Infant wide-field fundus photograph · 640 x 480 pixels:
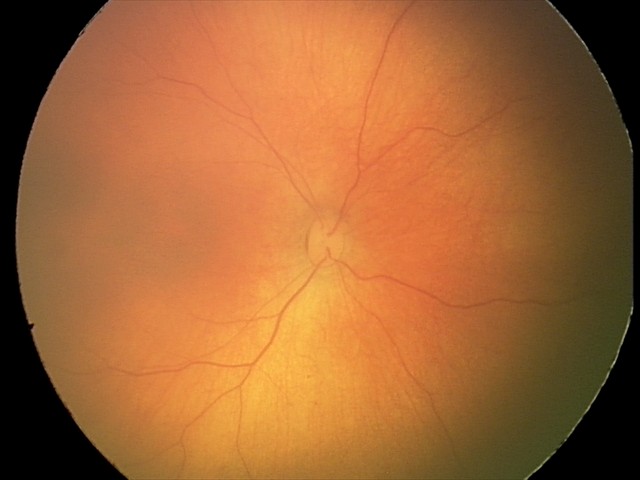
Normal screening examination.